45-degree field of view, 2048x1536px, color fundus image:
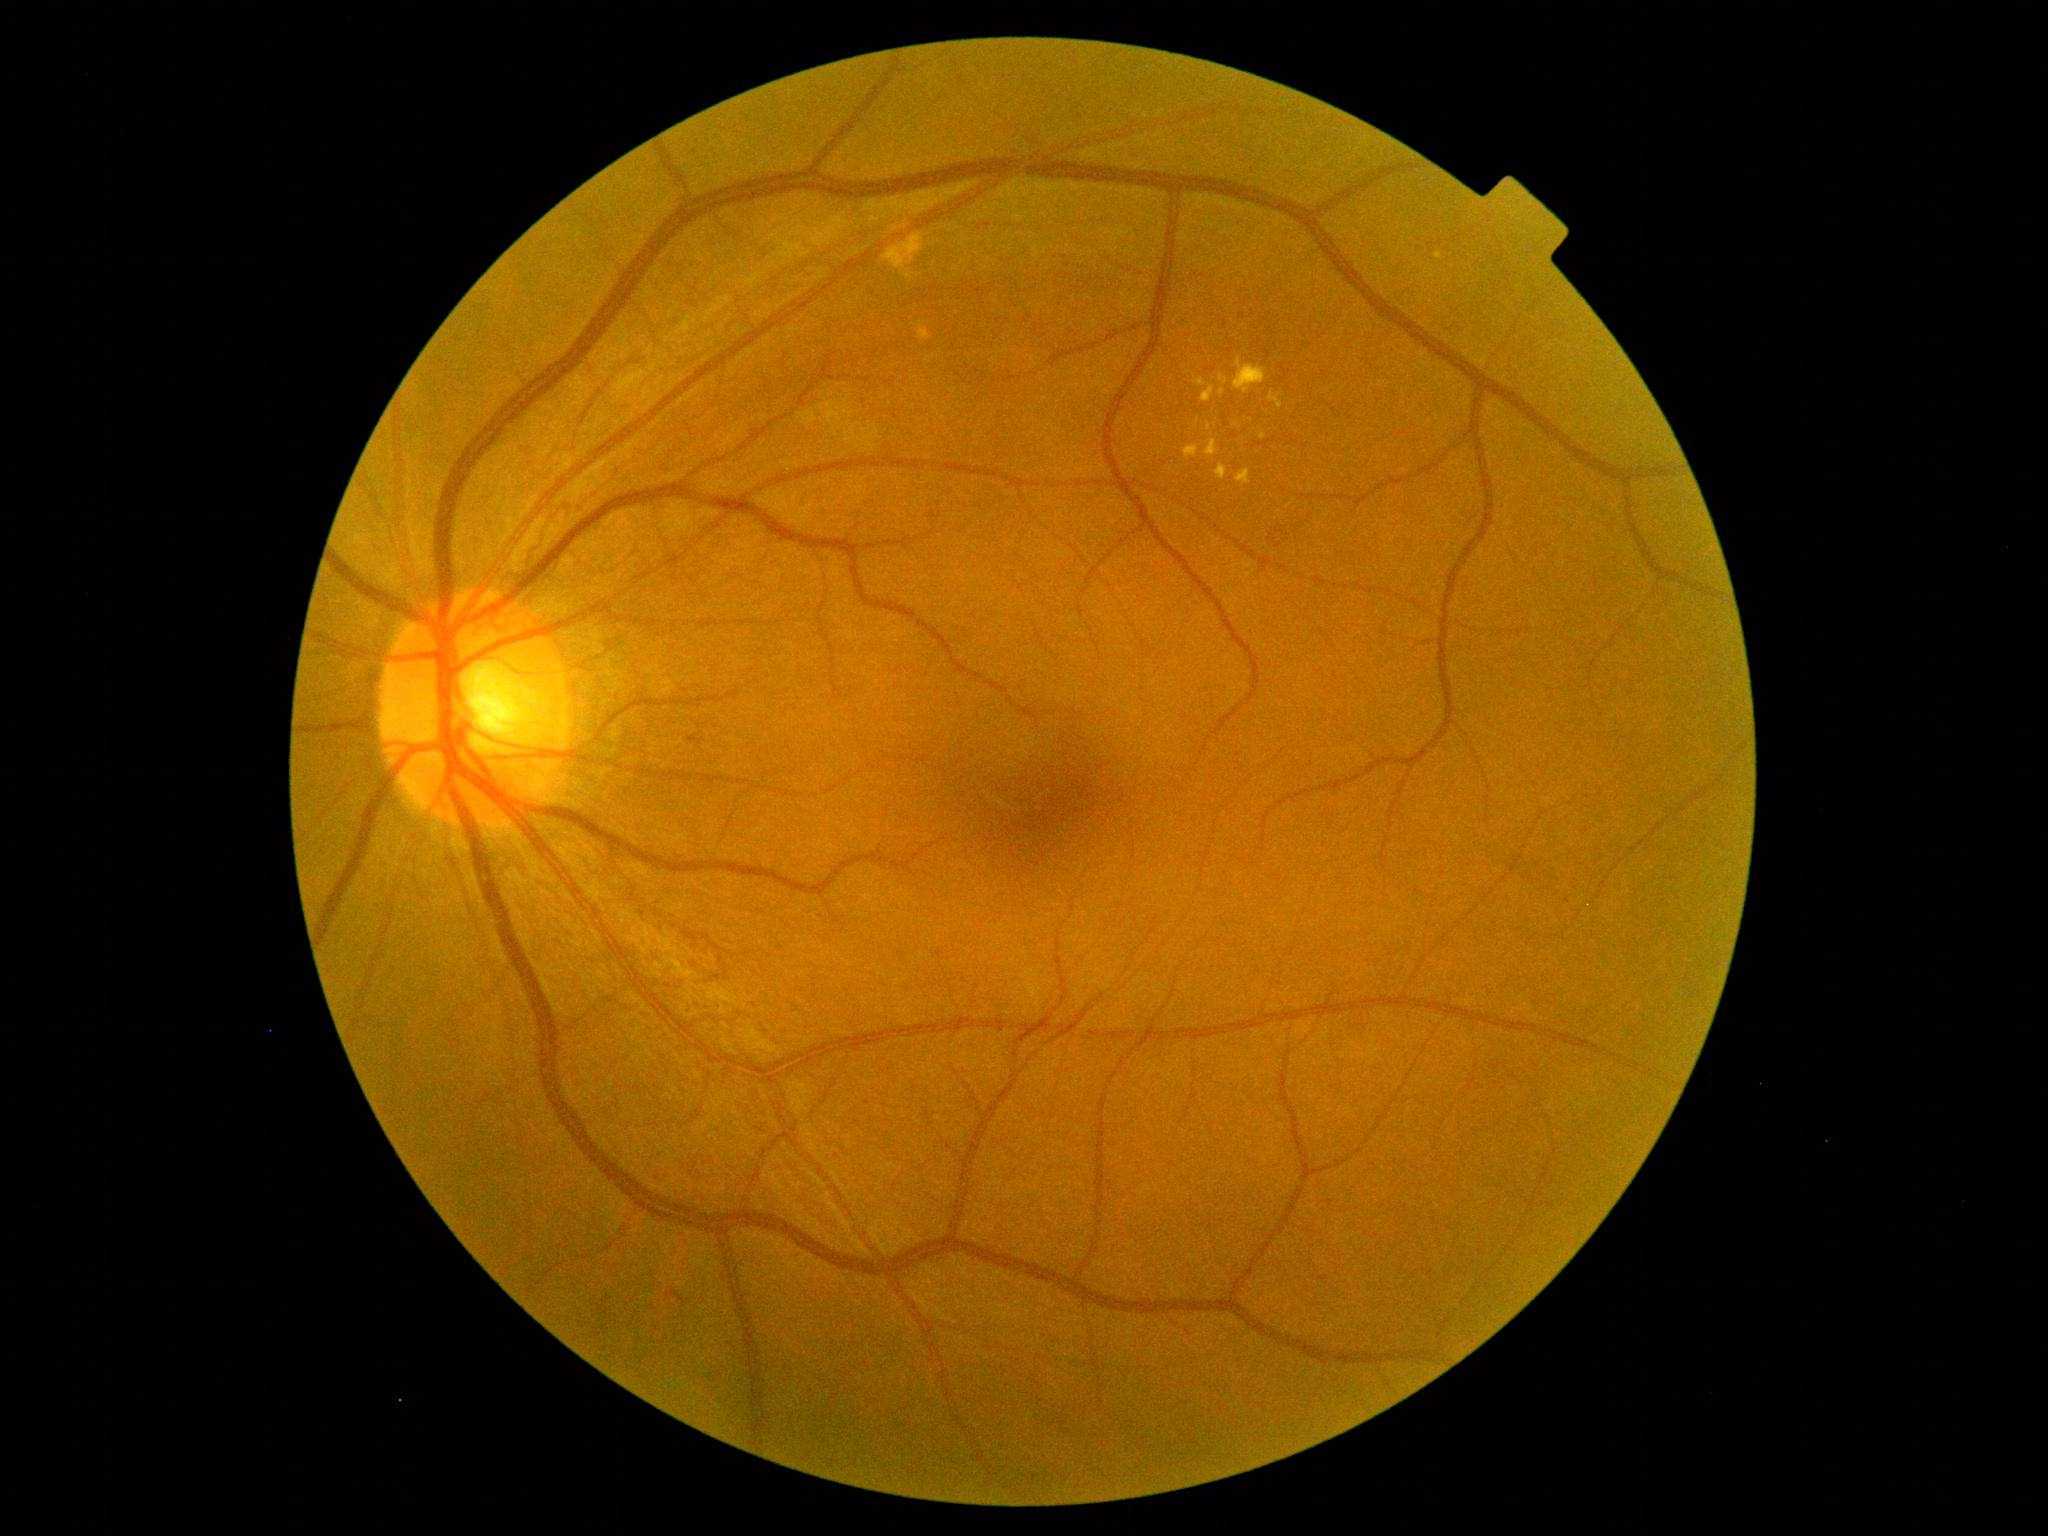
Diabetic retinopathy is 2/4 — more than just microaneurysms but less than severe NPDR.